Wide-field contact fundus photograph of an infant — 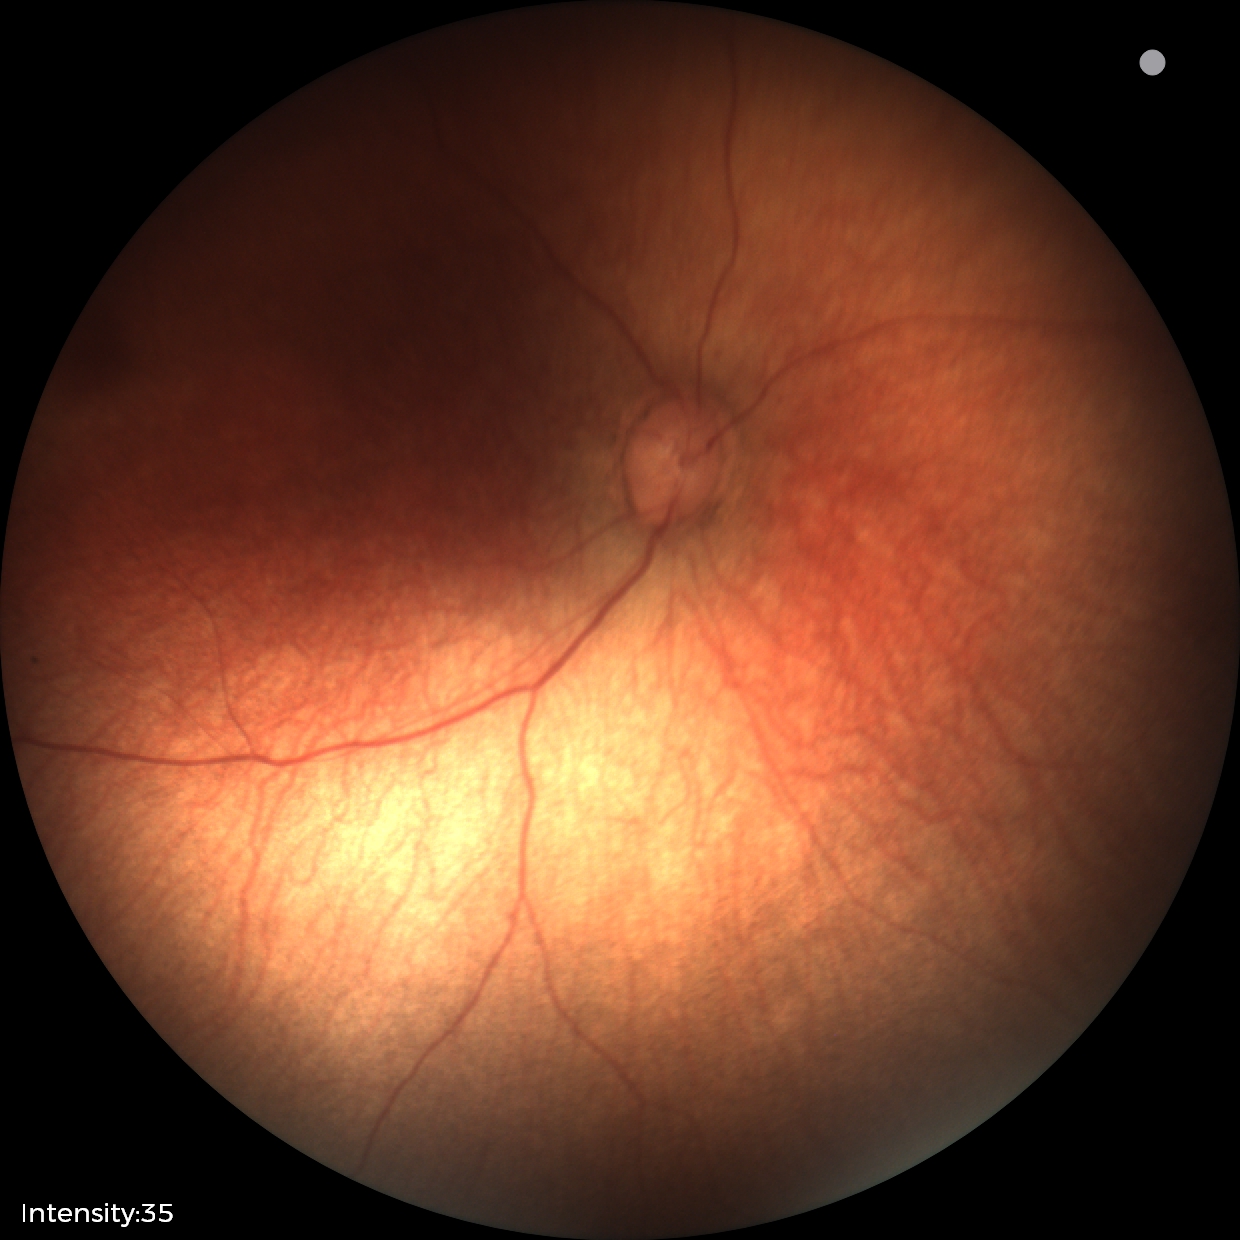

Screening examination diagnosed as physiological.